Image size 640x480. RetCam wide-field infant fundus image:
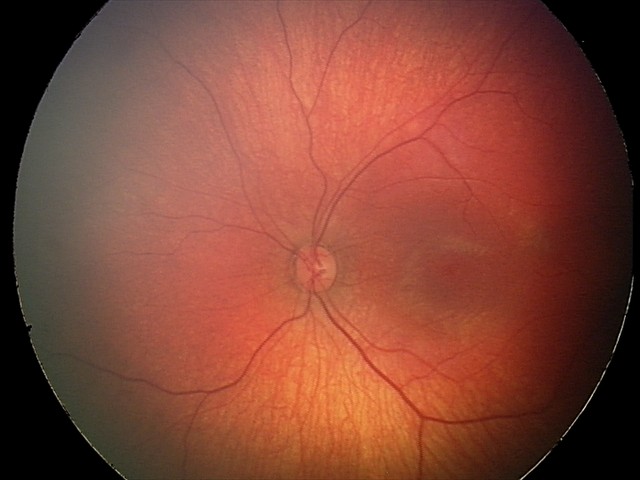 Screening: retinal hemorrhages.